Color fundus photograph. 2089x1764px: 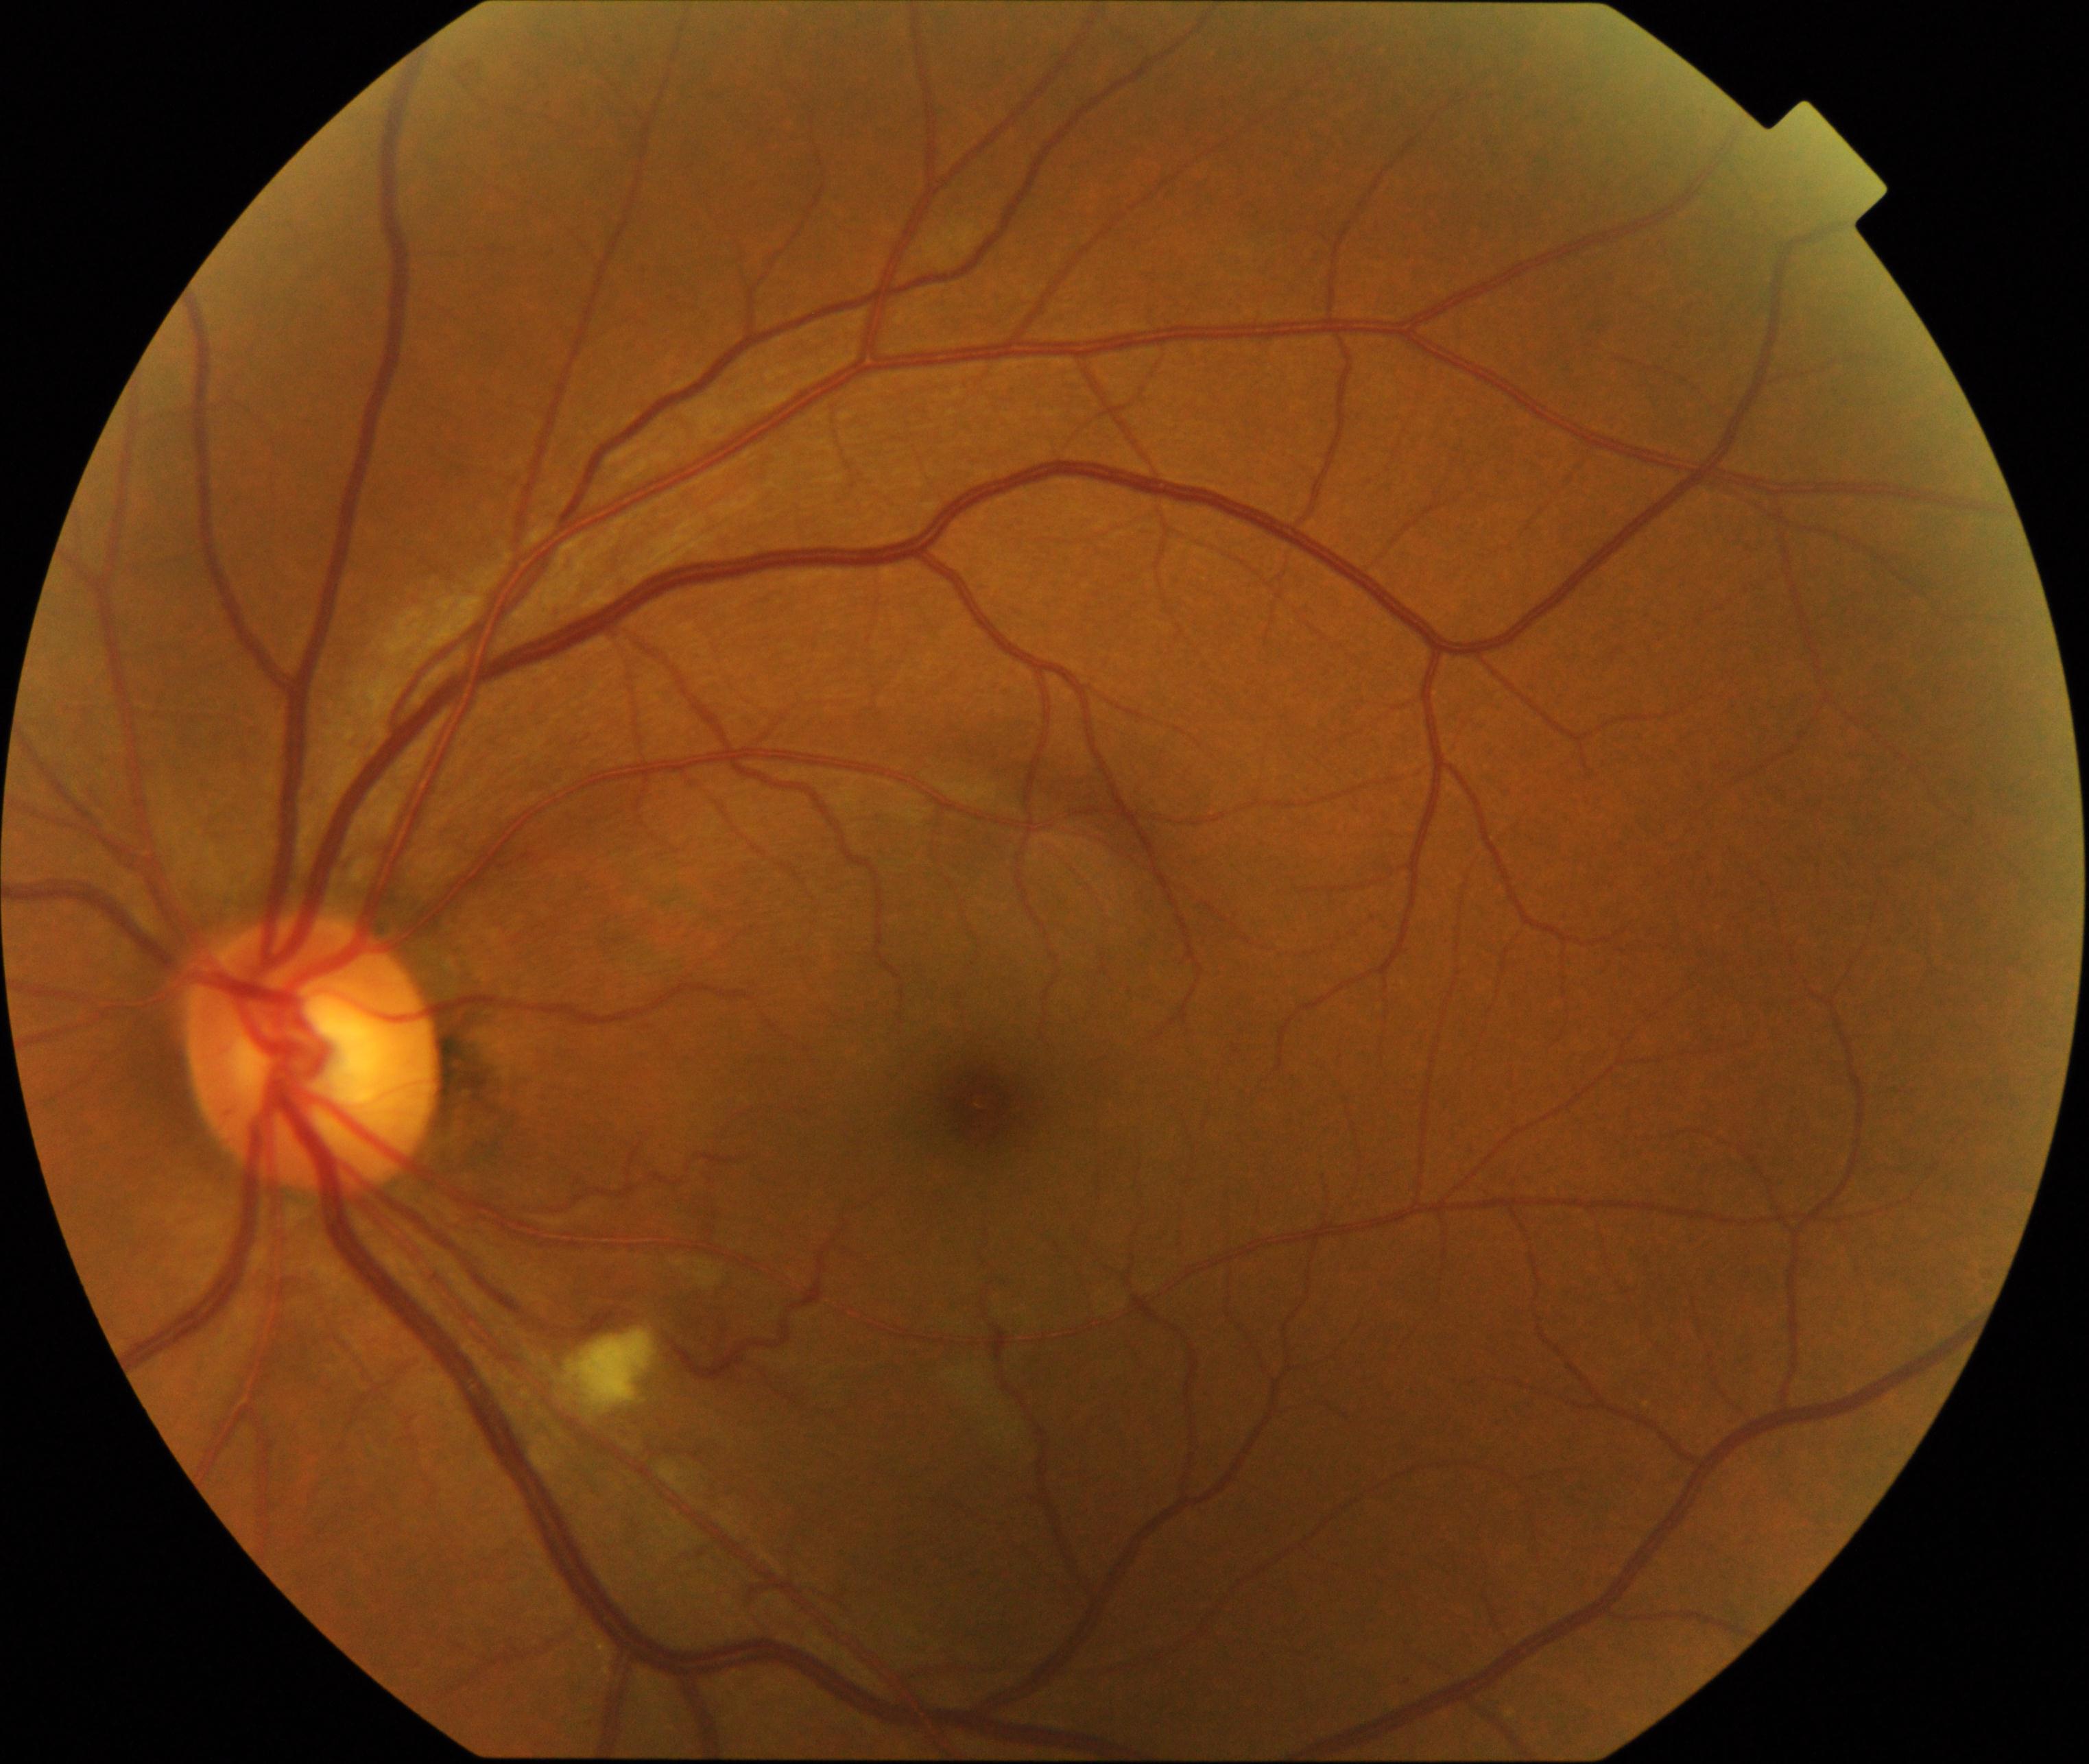

Consistent with cotton-wool spots.